45° field of view. 2352x1568px. CFP.
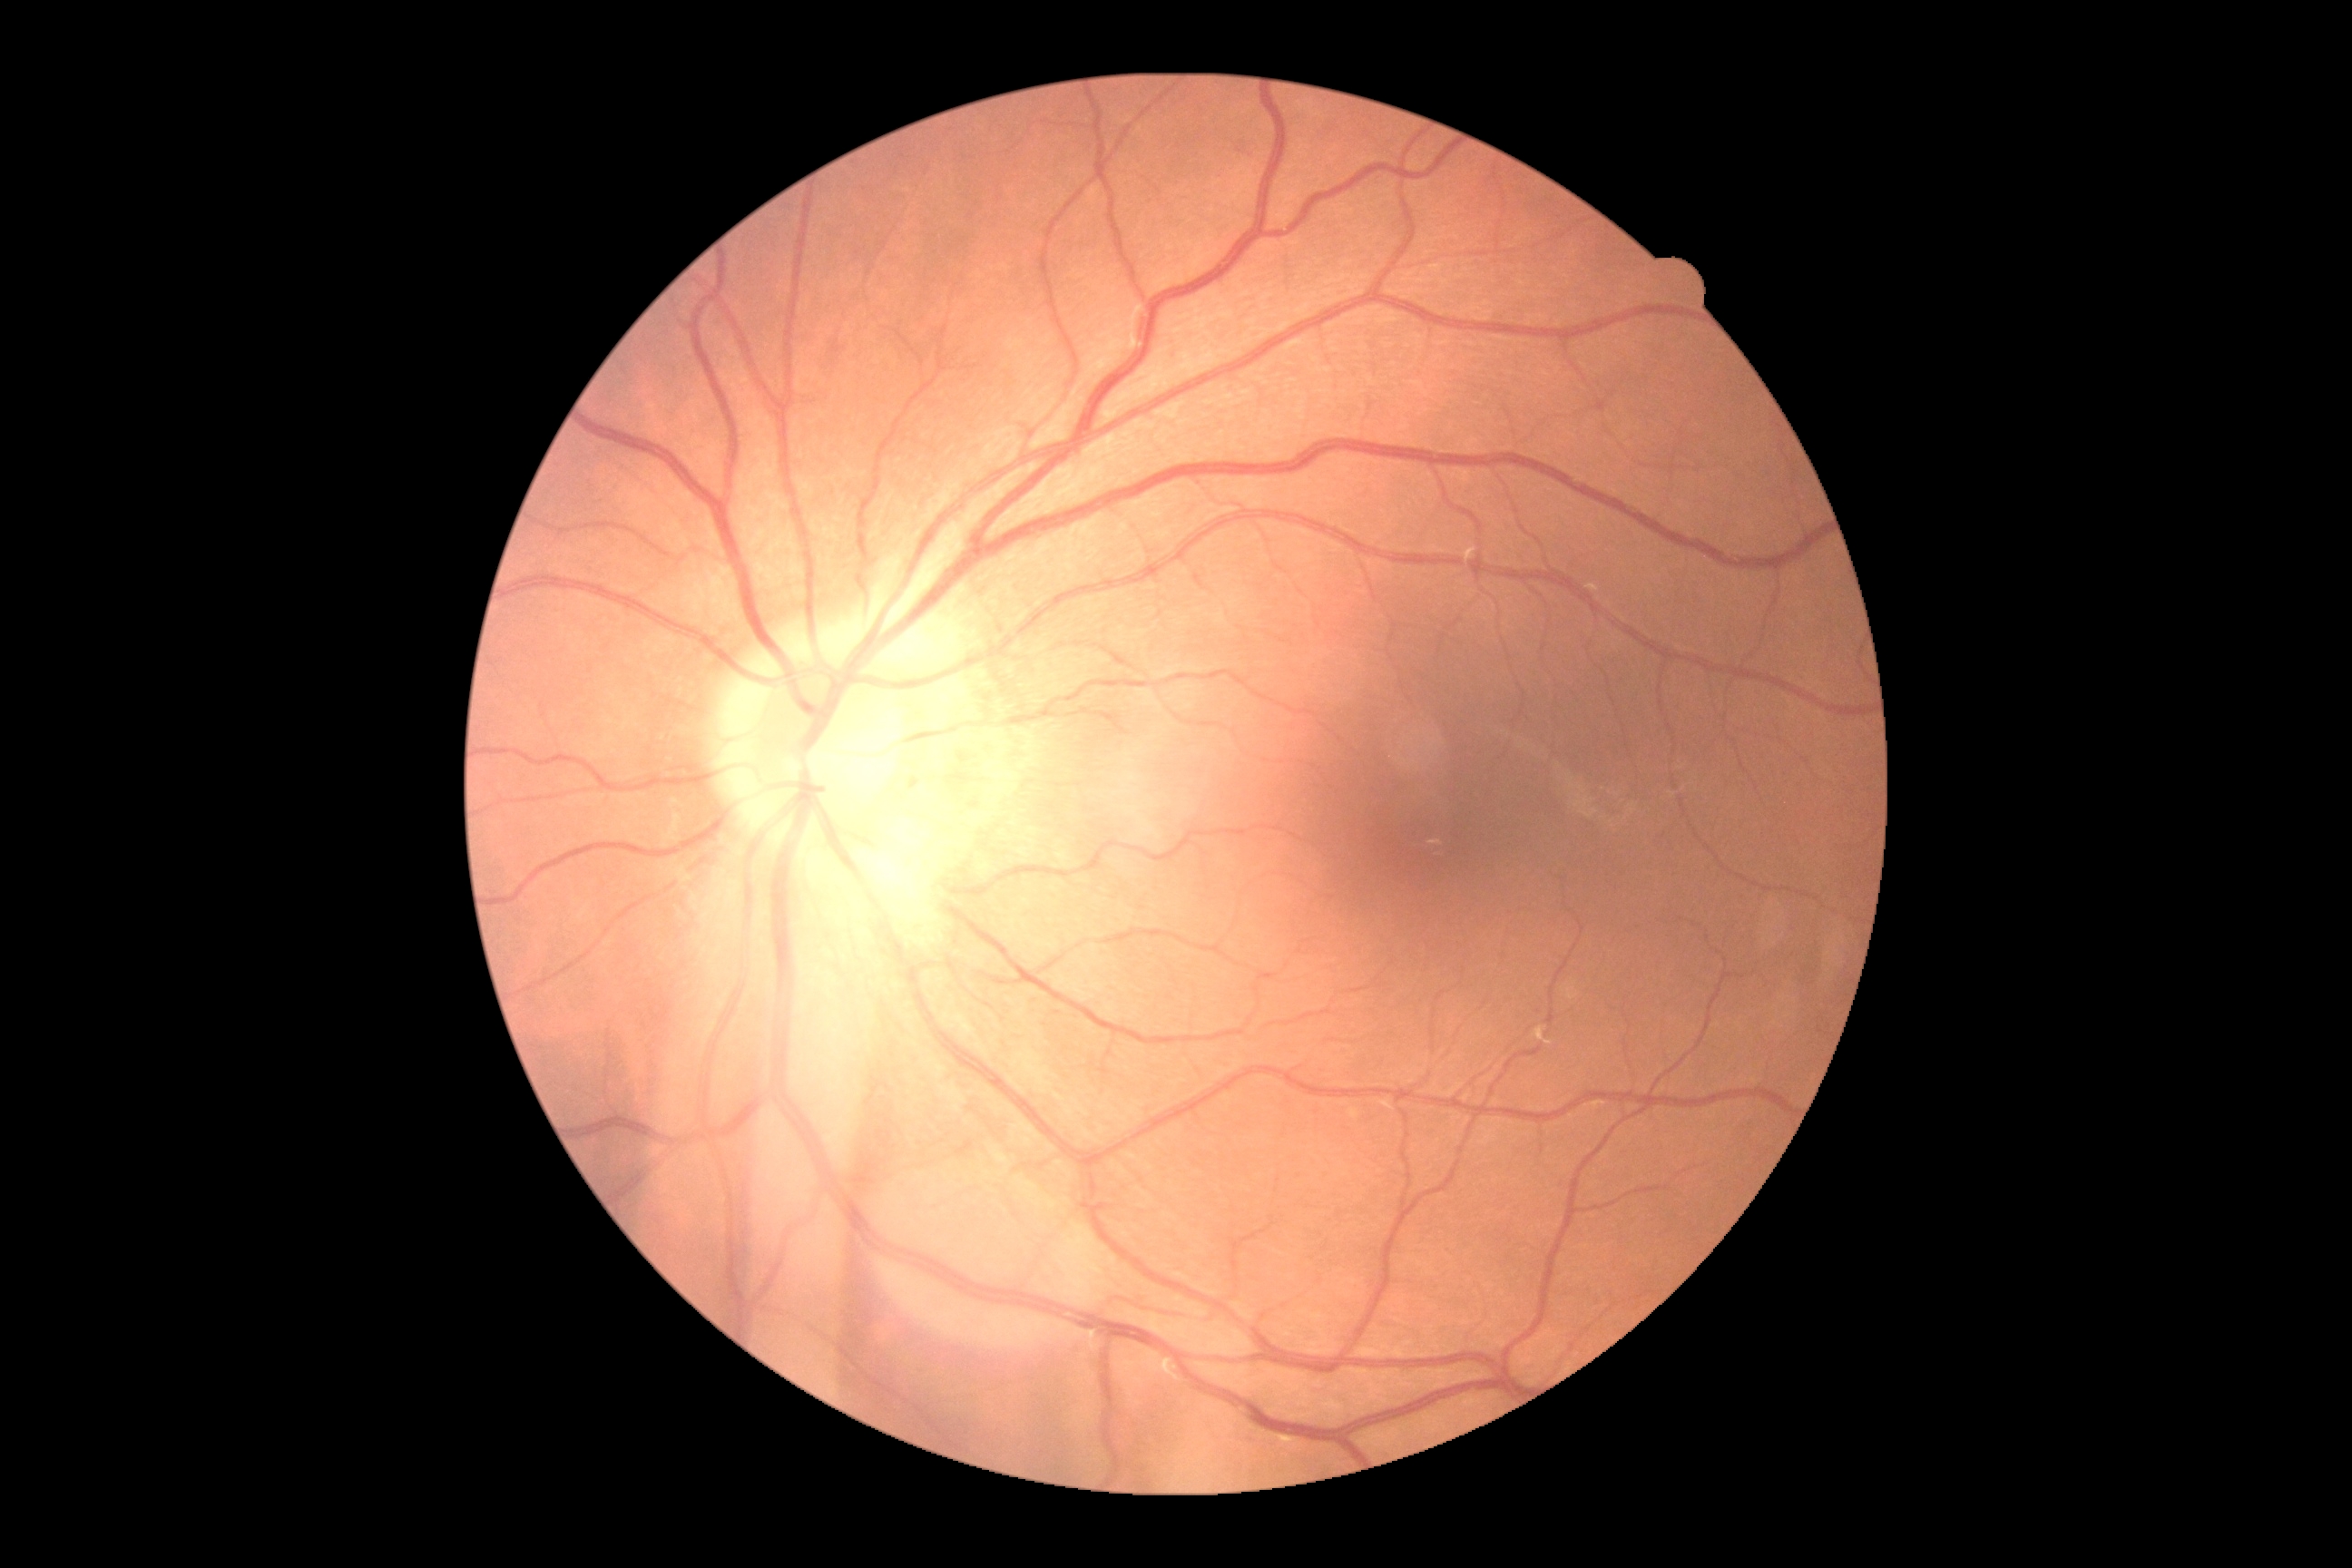

No apparent diabetic retinopathy.
DR grade is 0/4.